Fundus photo · 45° field of view · 2352 x 1568 pixels
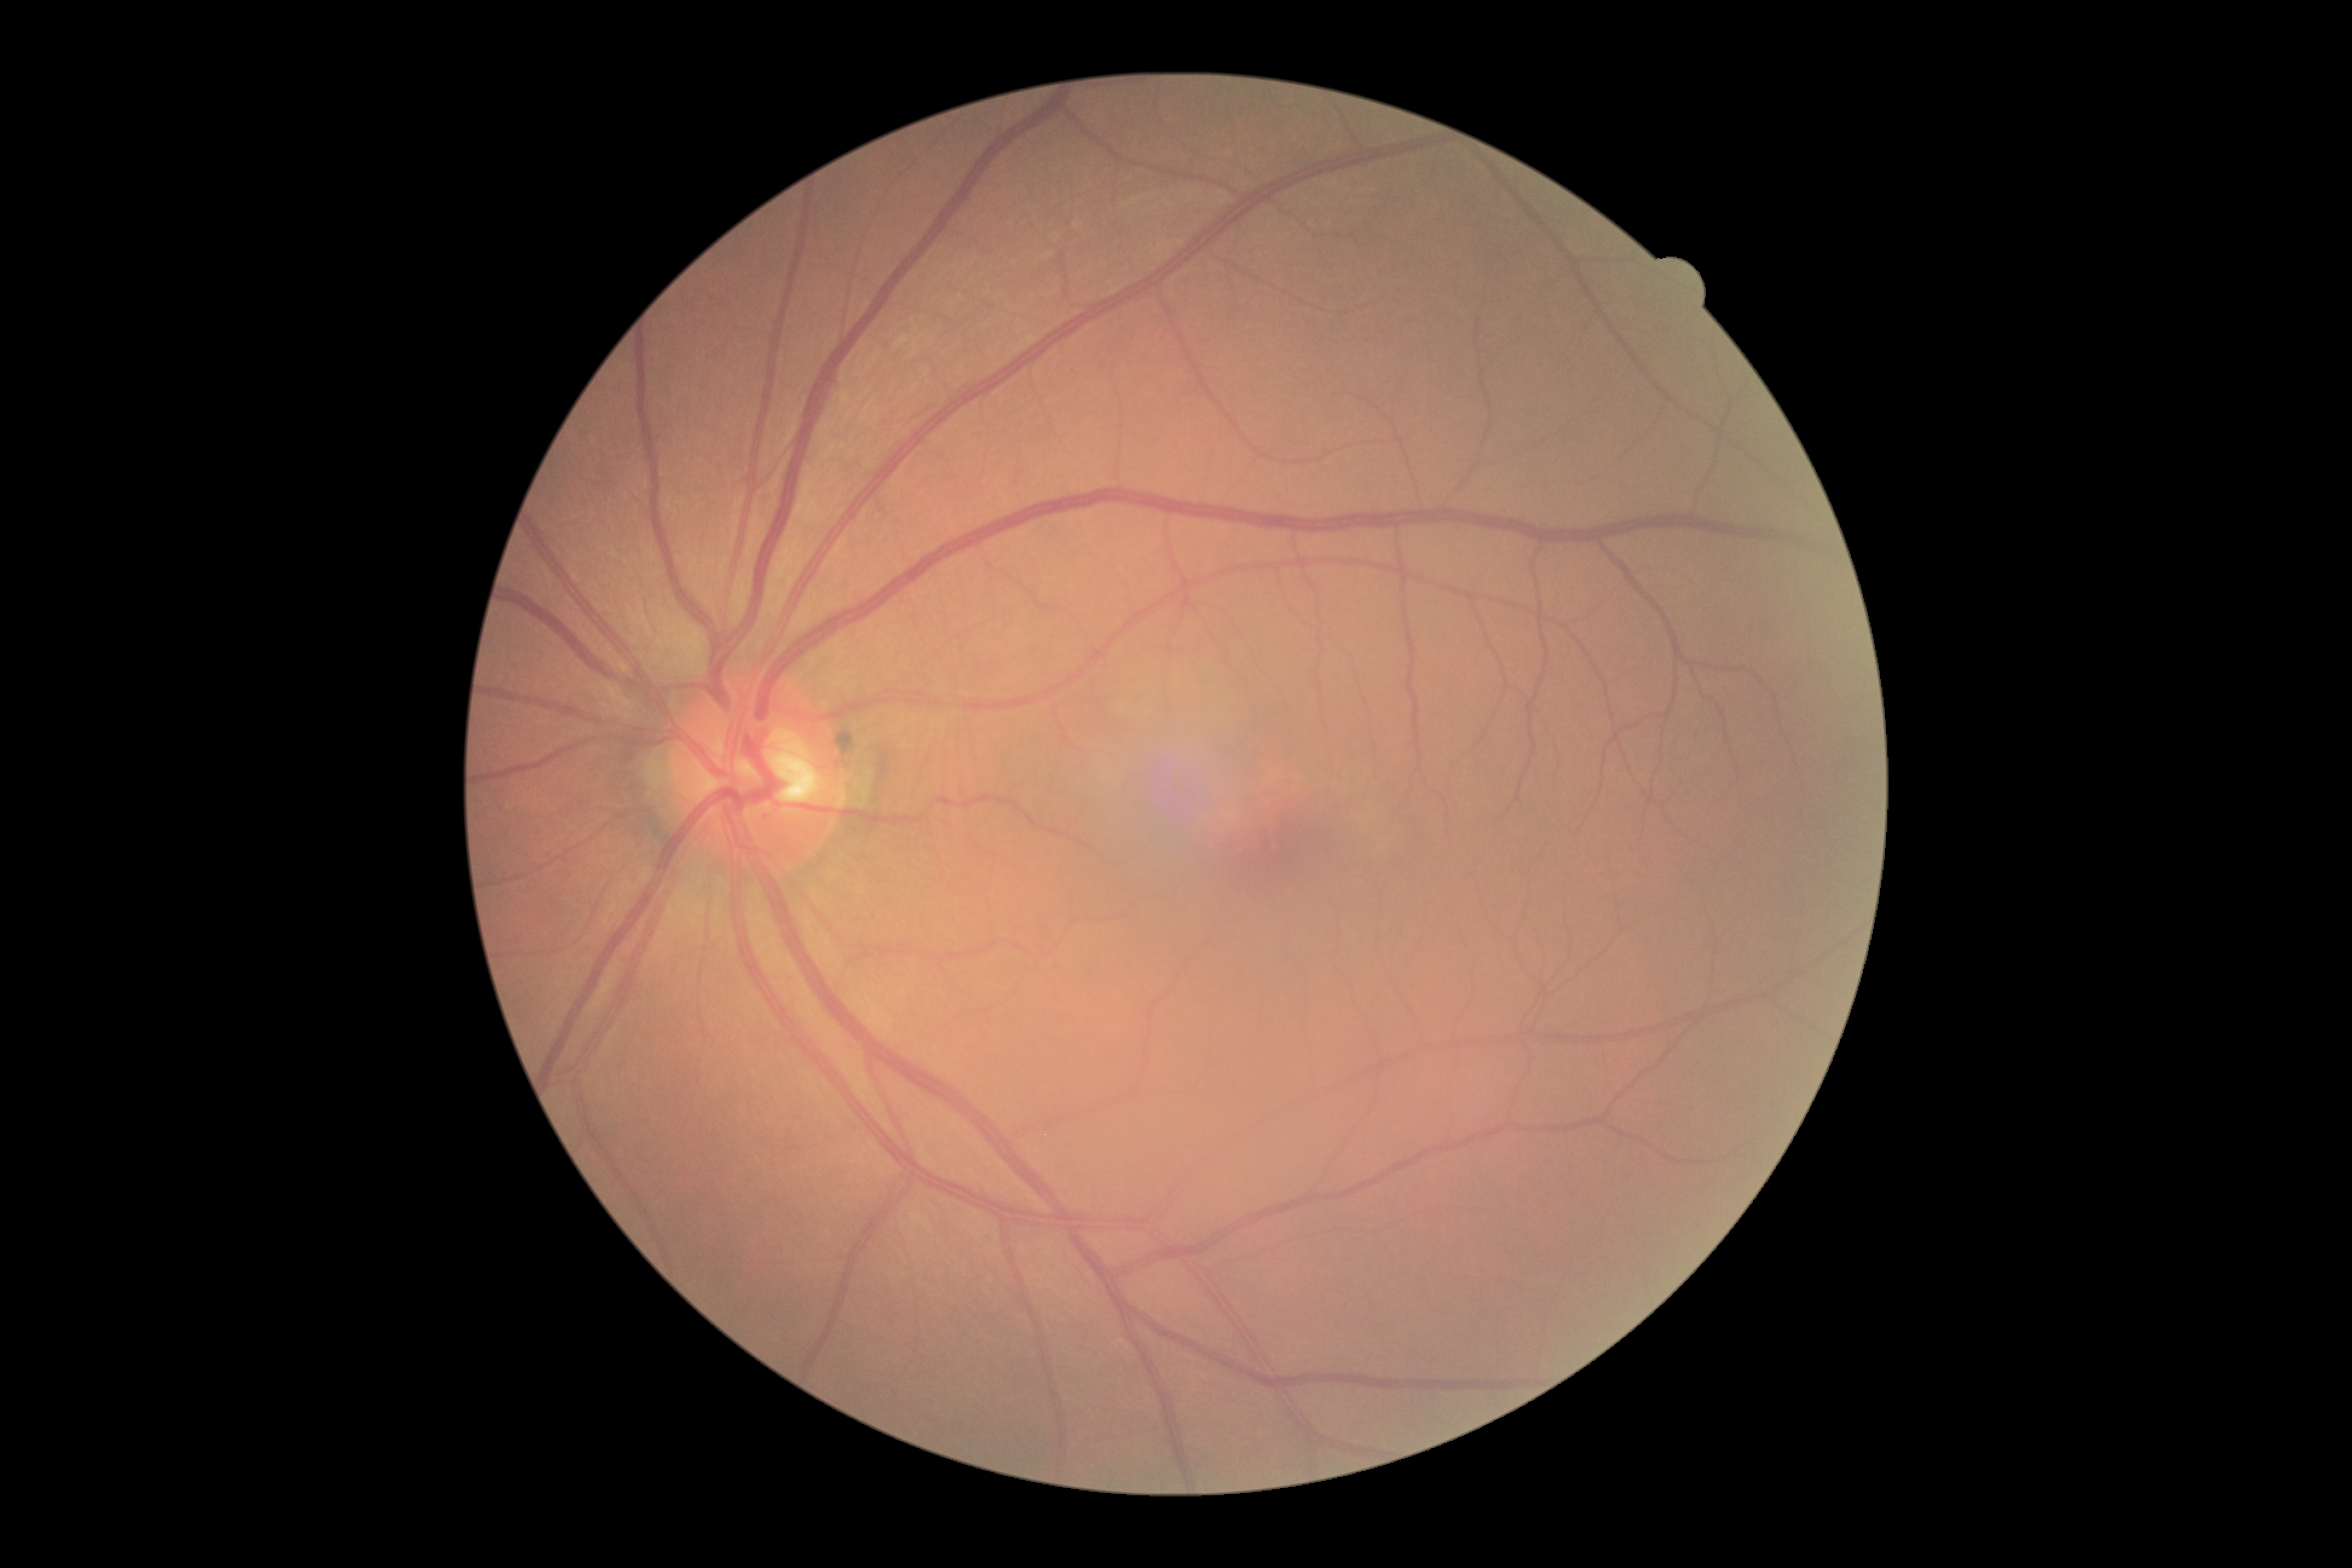
Annotations:
– DR severity — 0
– DR impression — no apparent DR